ONH-centered crop from a color fundus image: 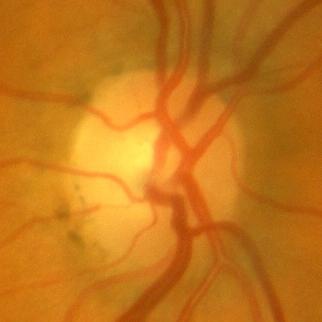 Showing no glaucomatous optic neuropathy.